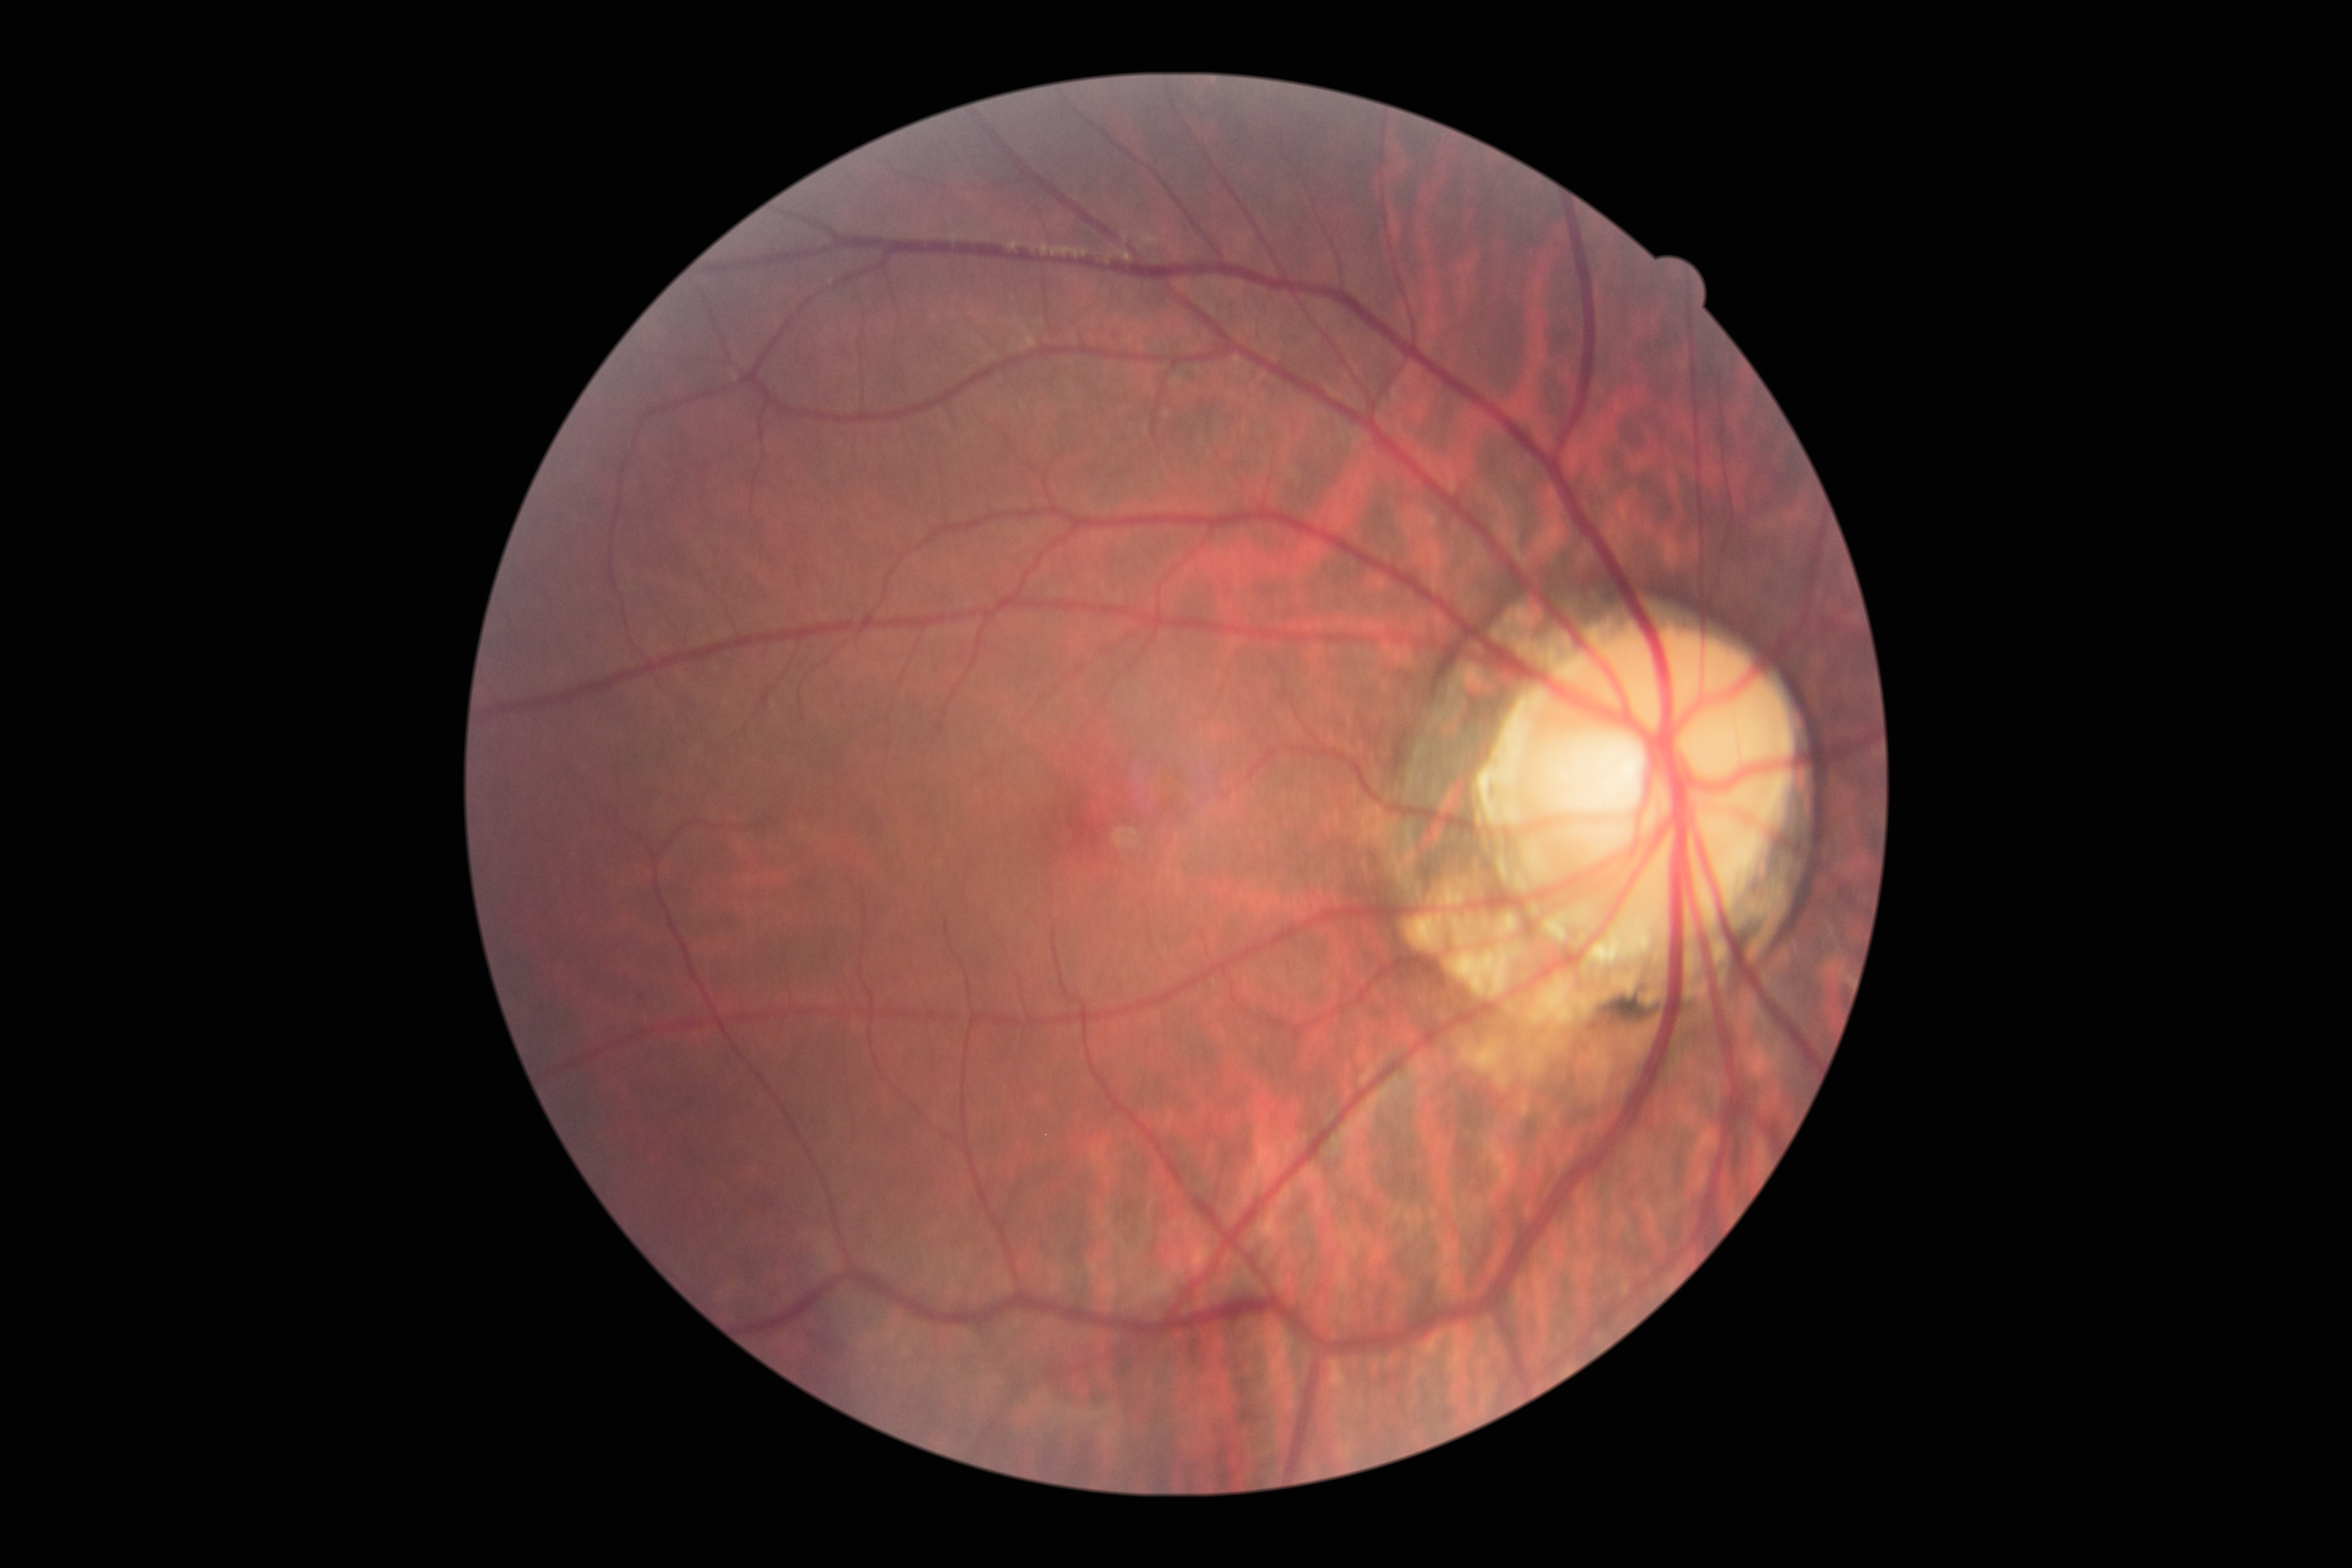

Findings:
– DR impression — no apparent DR
– DR stage — 0/4